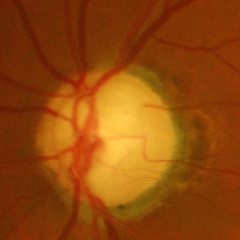 Q: What stage of glaucoma is present?
A: Yes — severe glaucomatous damage.